Captured on a Nidek AFC-330 fundus camera — 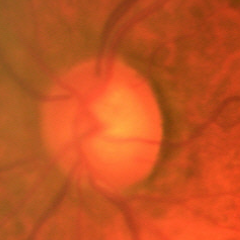
Q: What is the glaucoma diagnosis?
A: Early glaucomatous optic neuropathy.